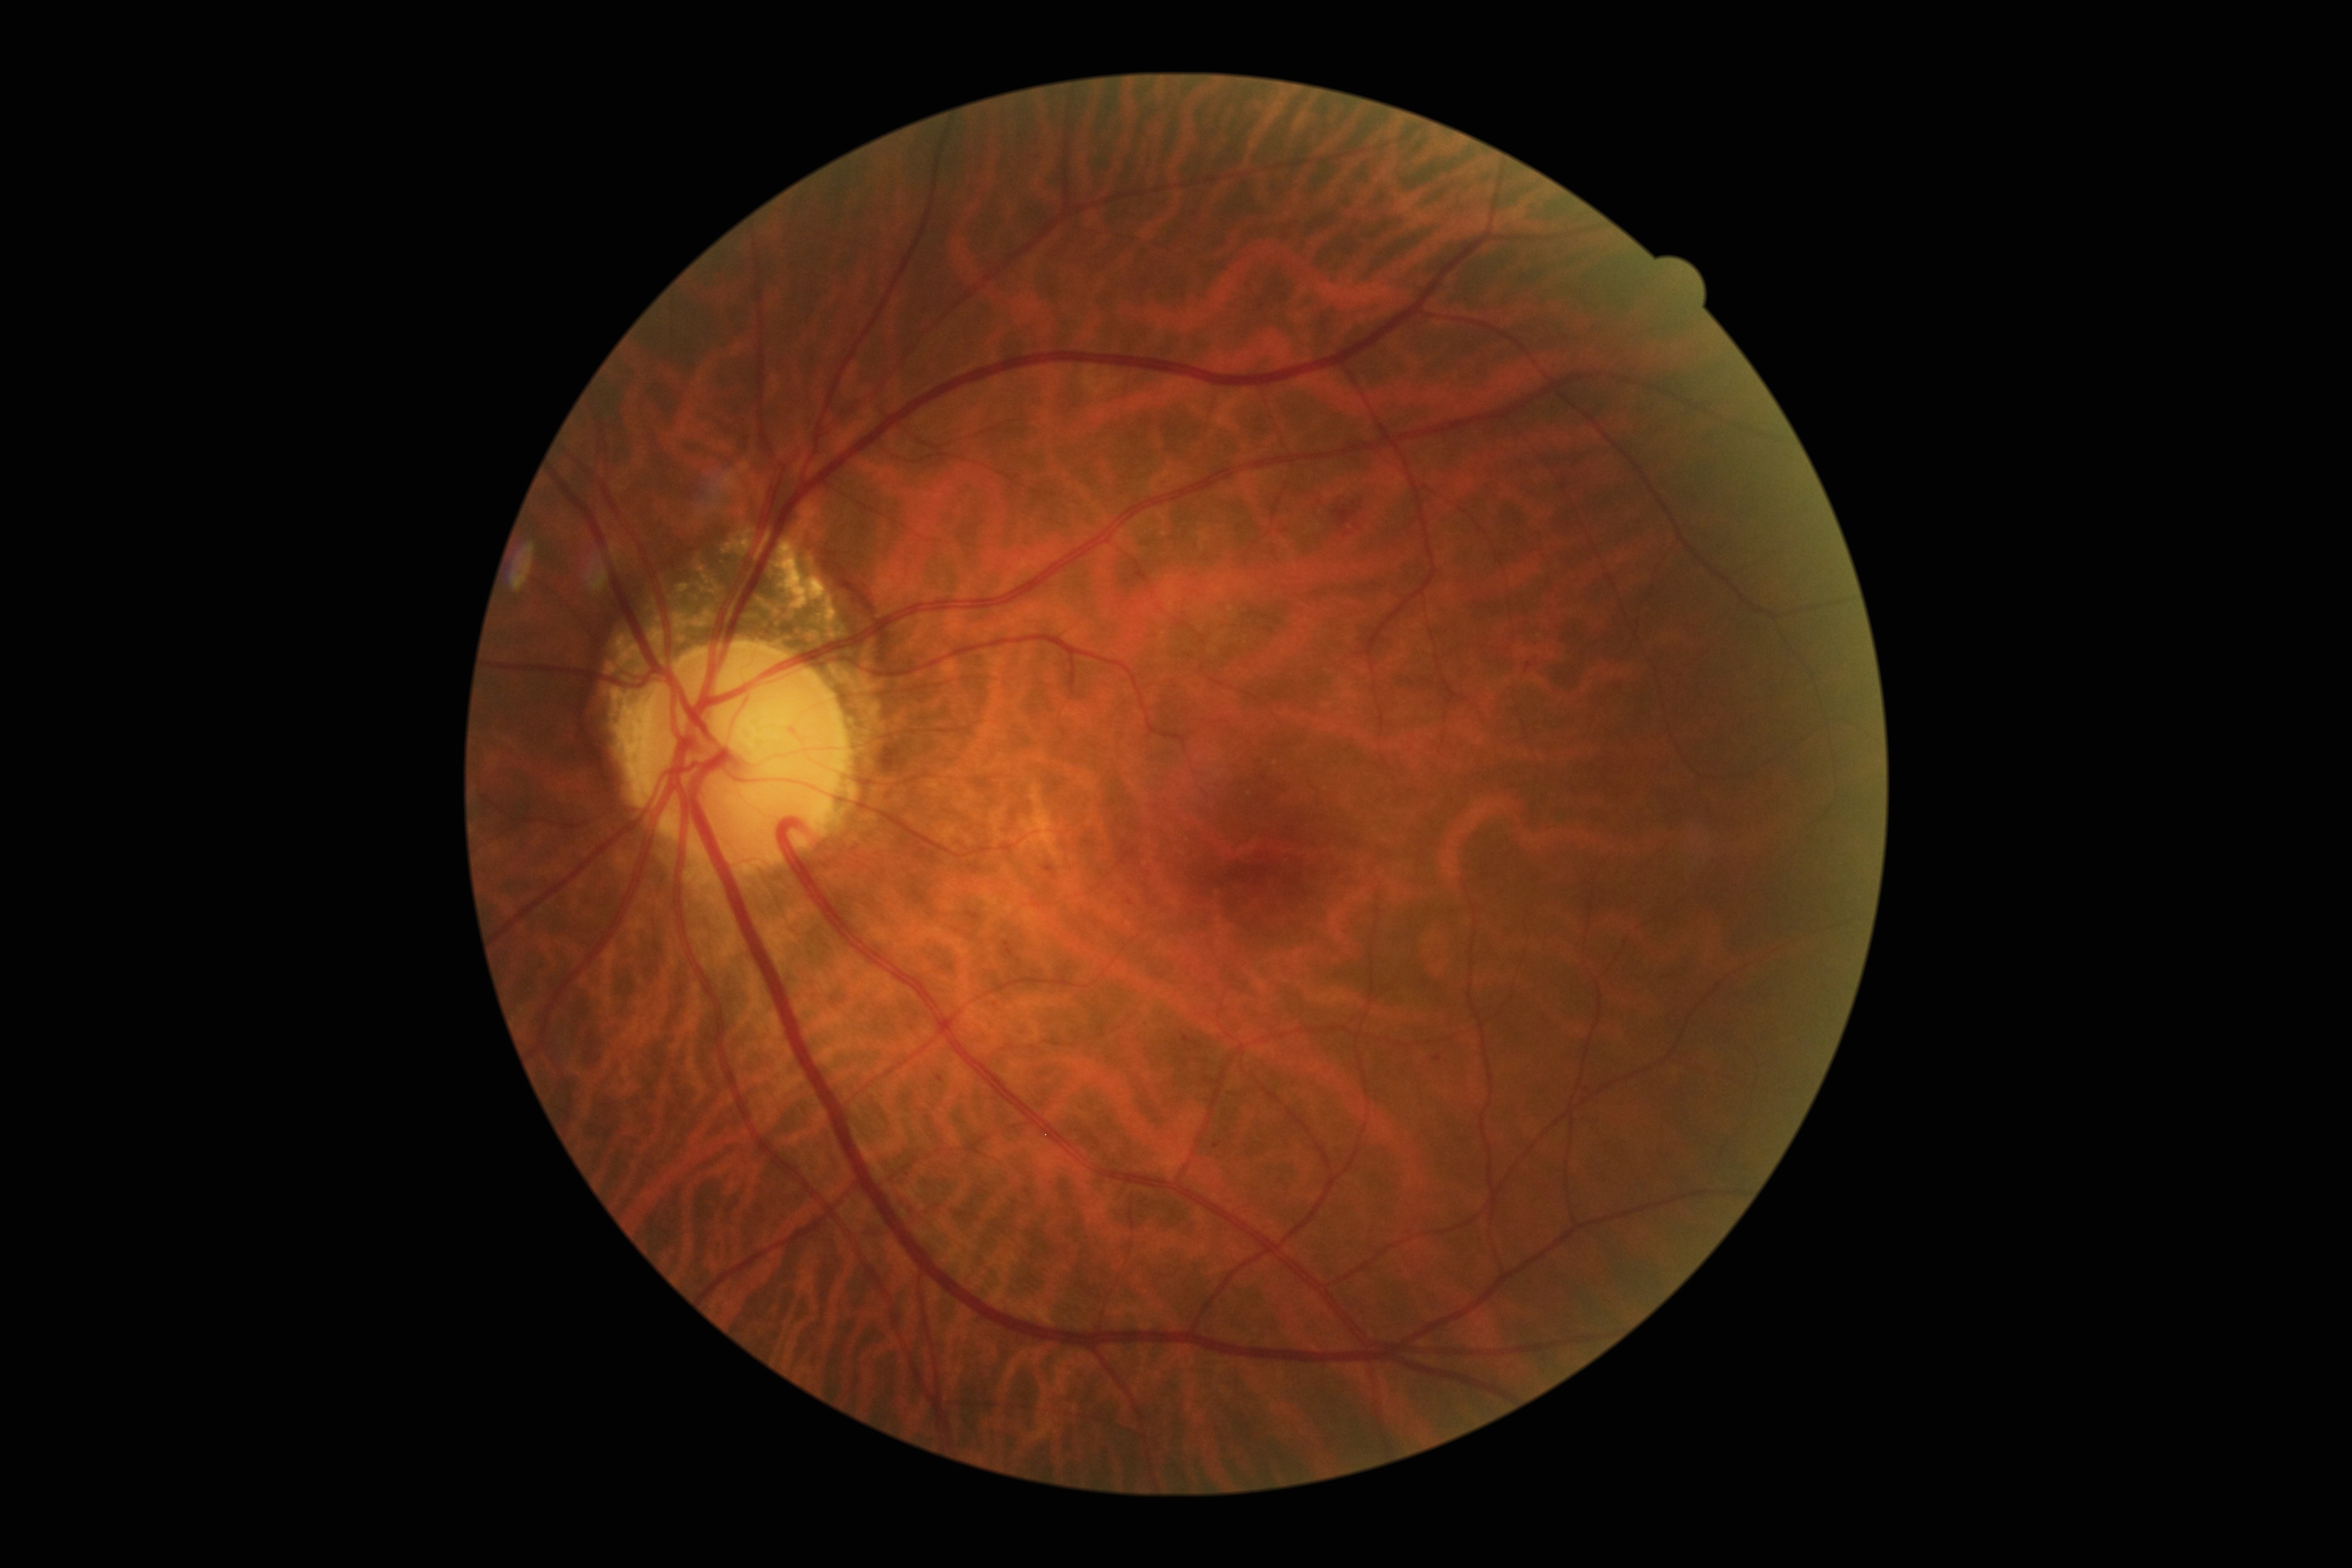

The retinopathy is classified as non-proliferative diabetic retinopathy. DR severity is grade 2 (moderate NPDR).